Acquired with a Remidio Fundus on Phone.
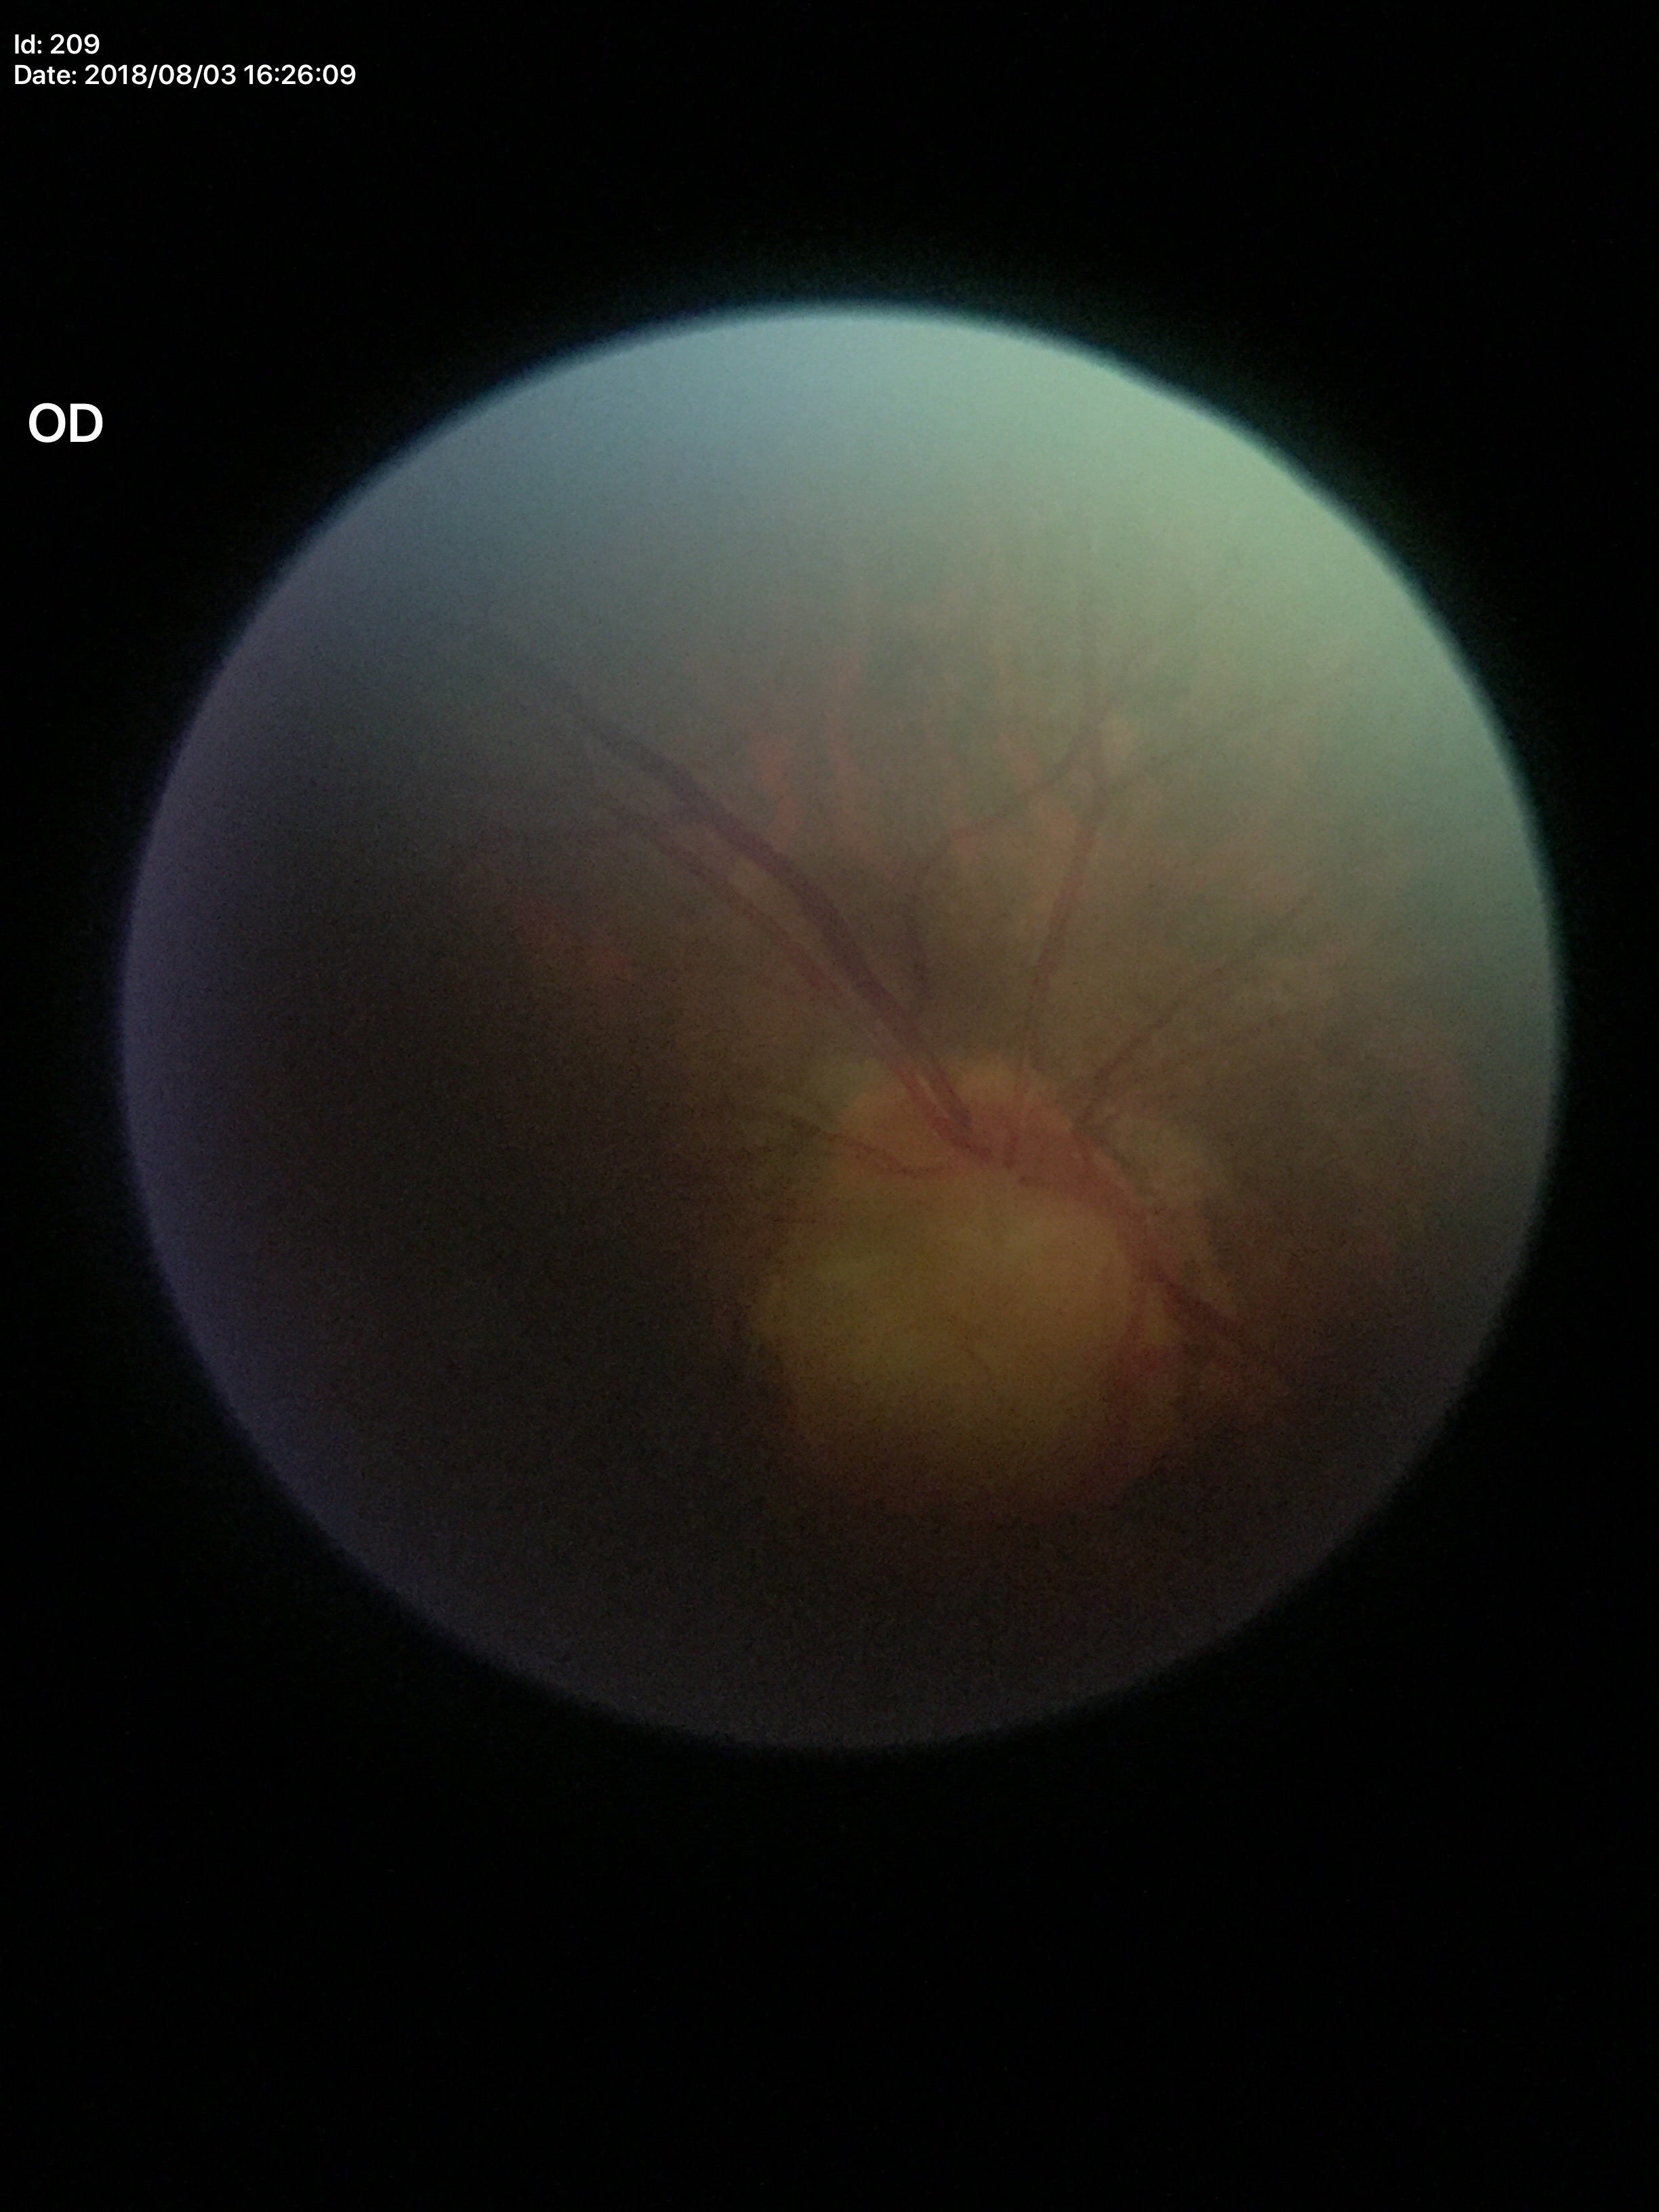 Findings:
- Glaucoma decision — suspicious findings (5/5 ophthalmologists in agreement)
- vertical C/D ratio — 0.71
- horizontal C/D ratio — 0.74